Wide-field fundus photograph of an infant; 1240 by 1240 pixels.
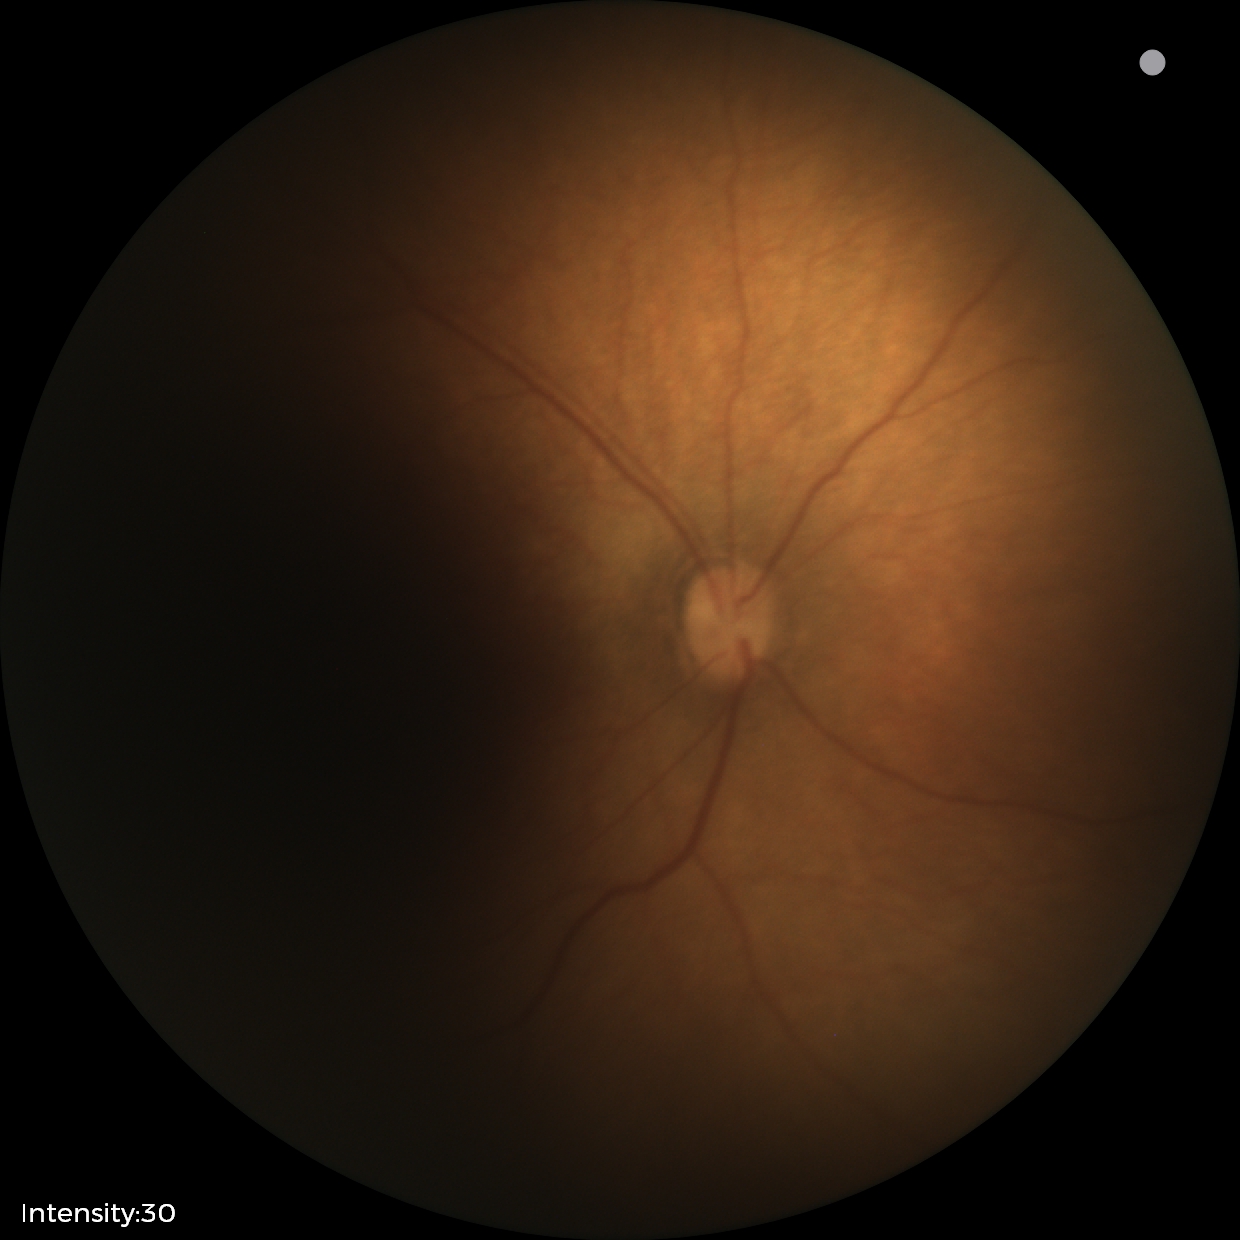 Diagnosis = no abnormalities.